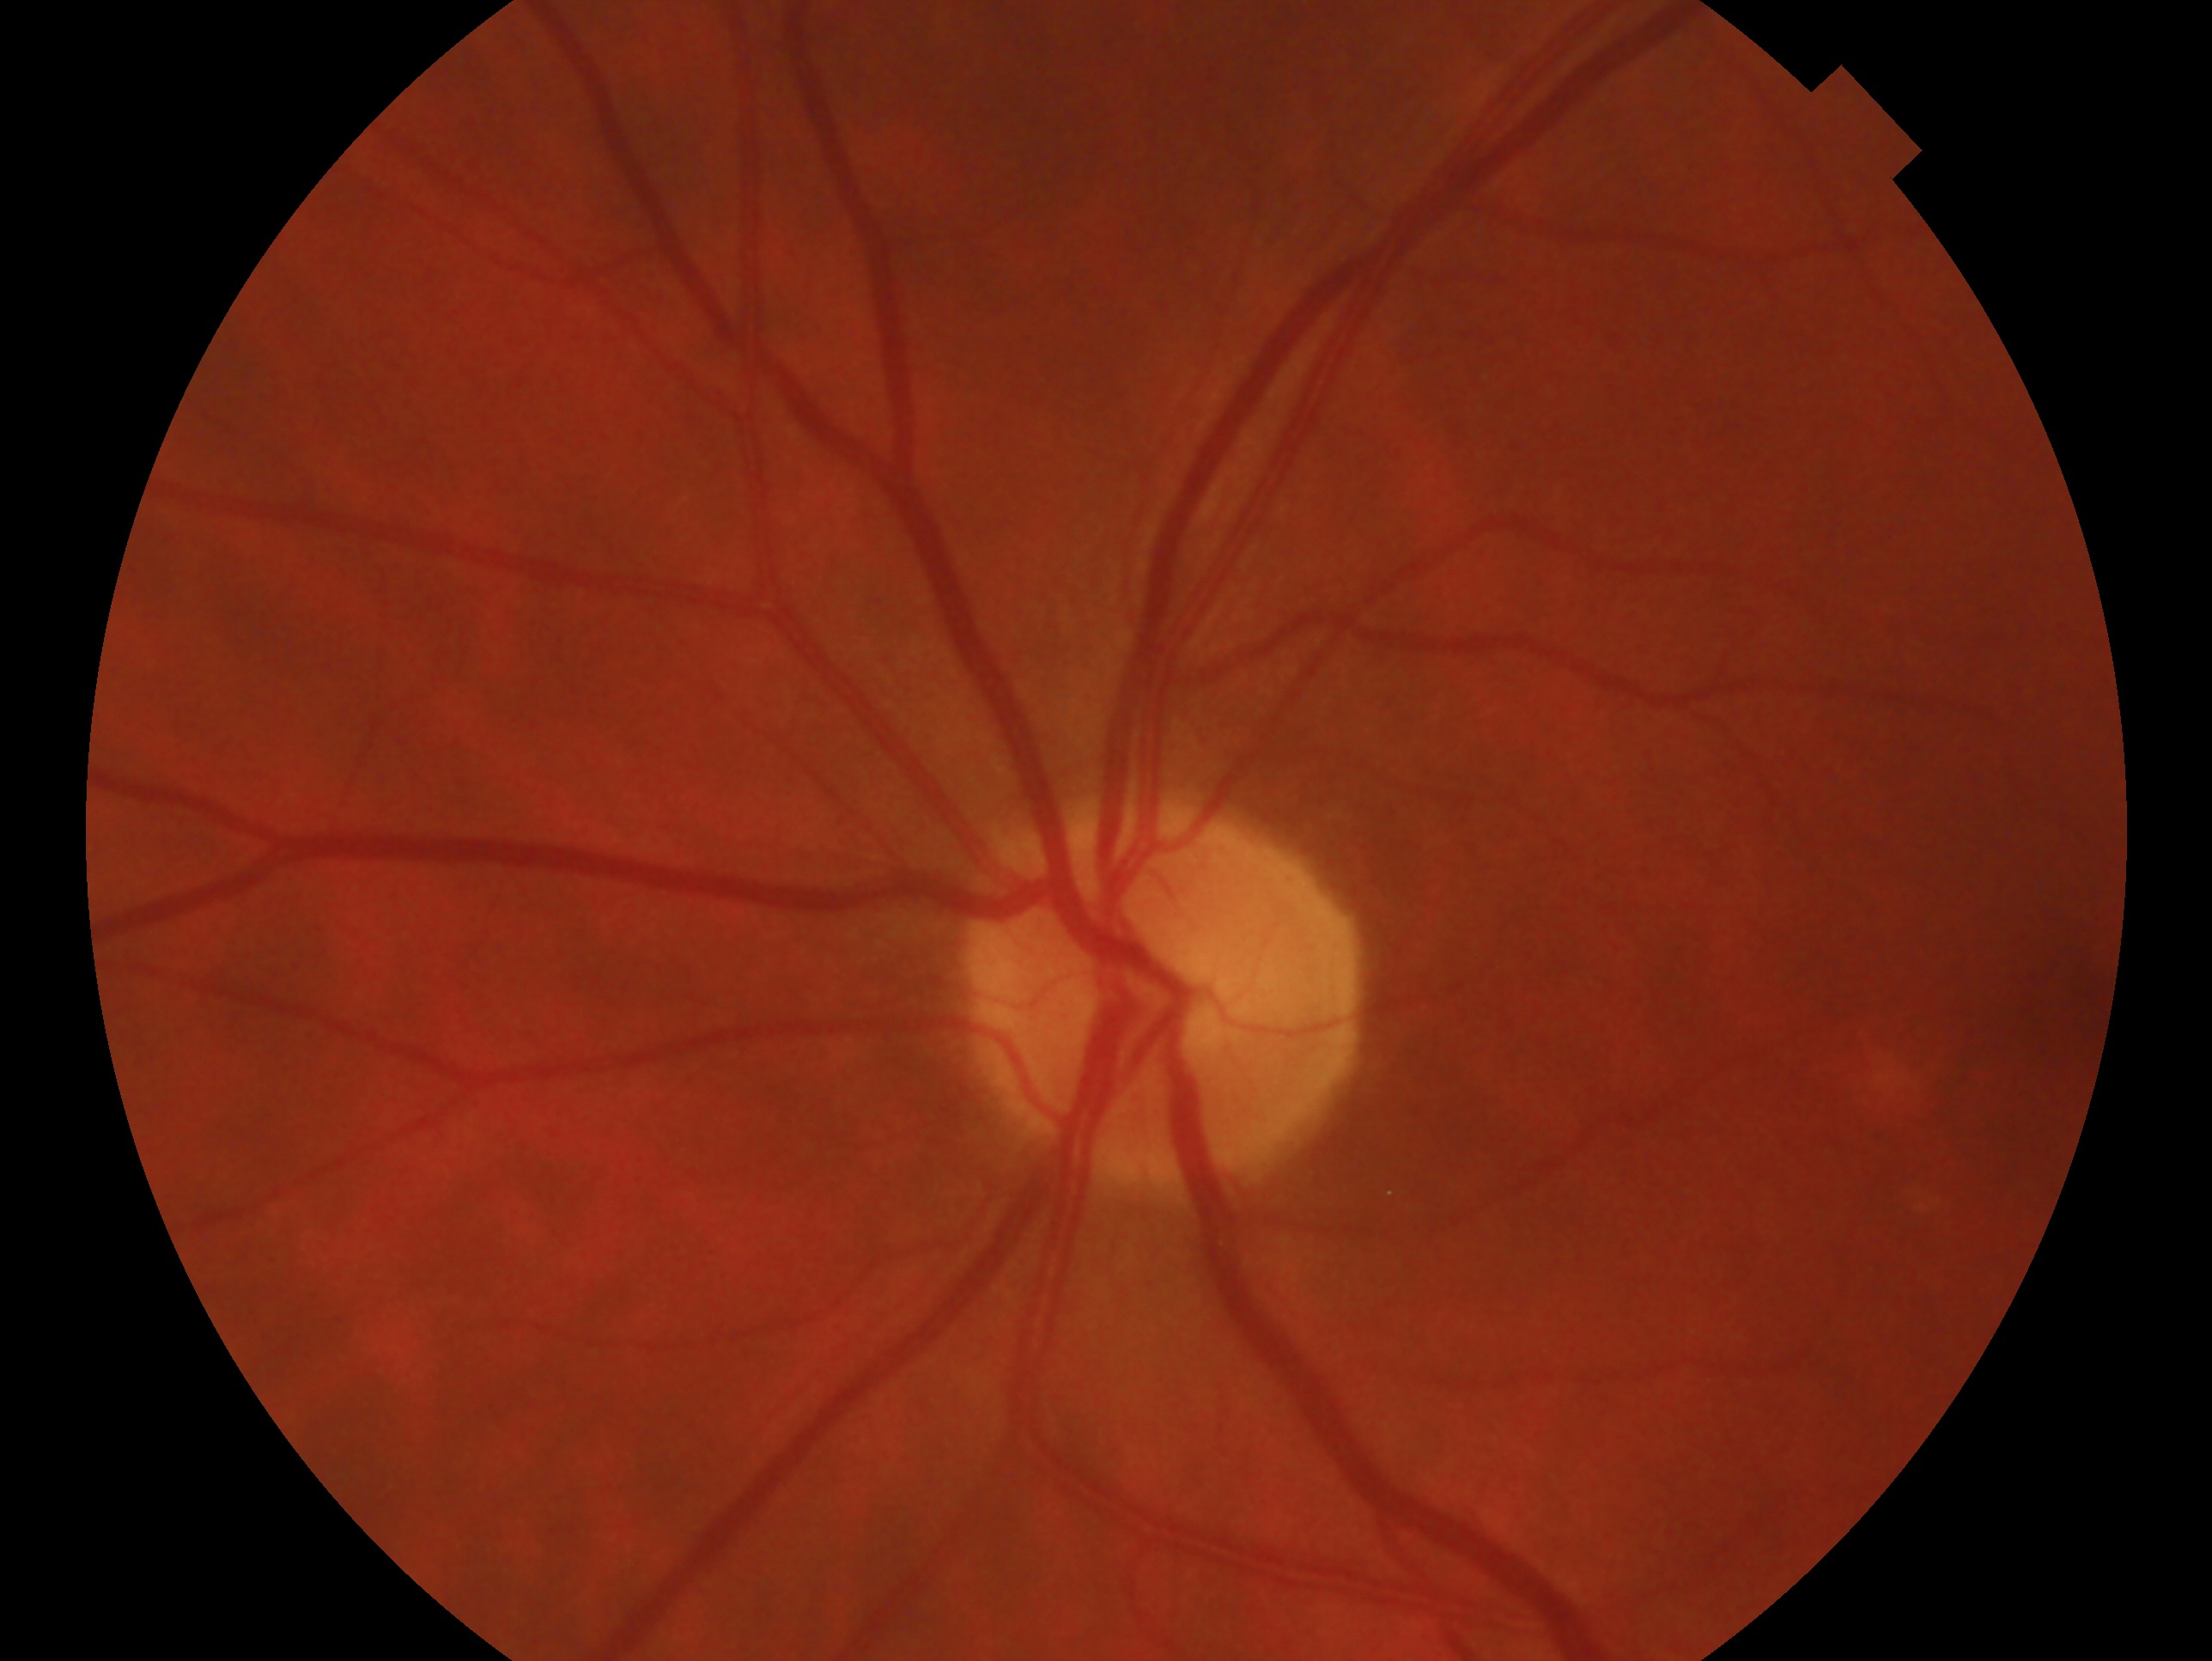 The image shows the oculus sinister.
Glaucoma status — no signs of glaucoma.